Color fundus photograph: 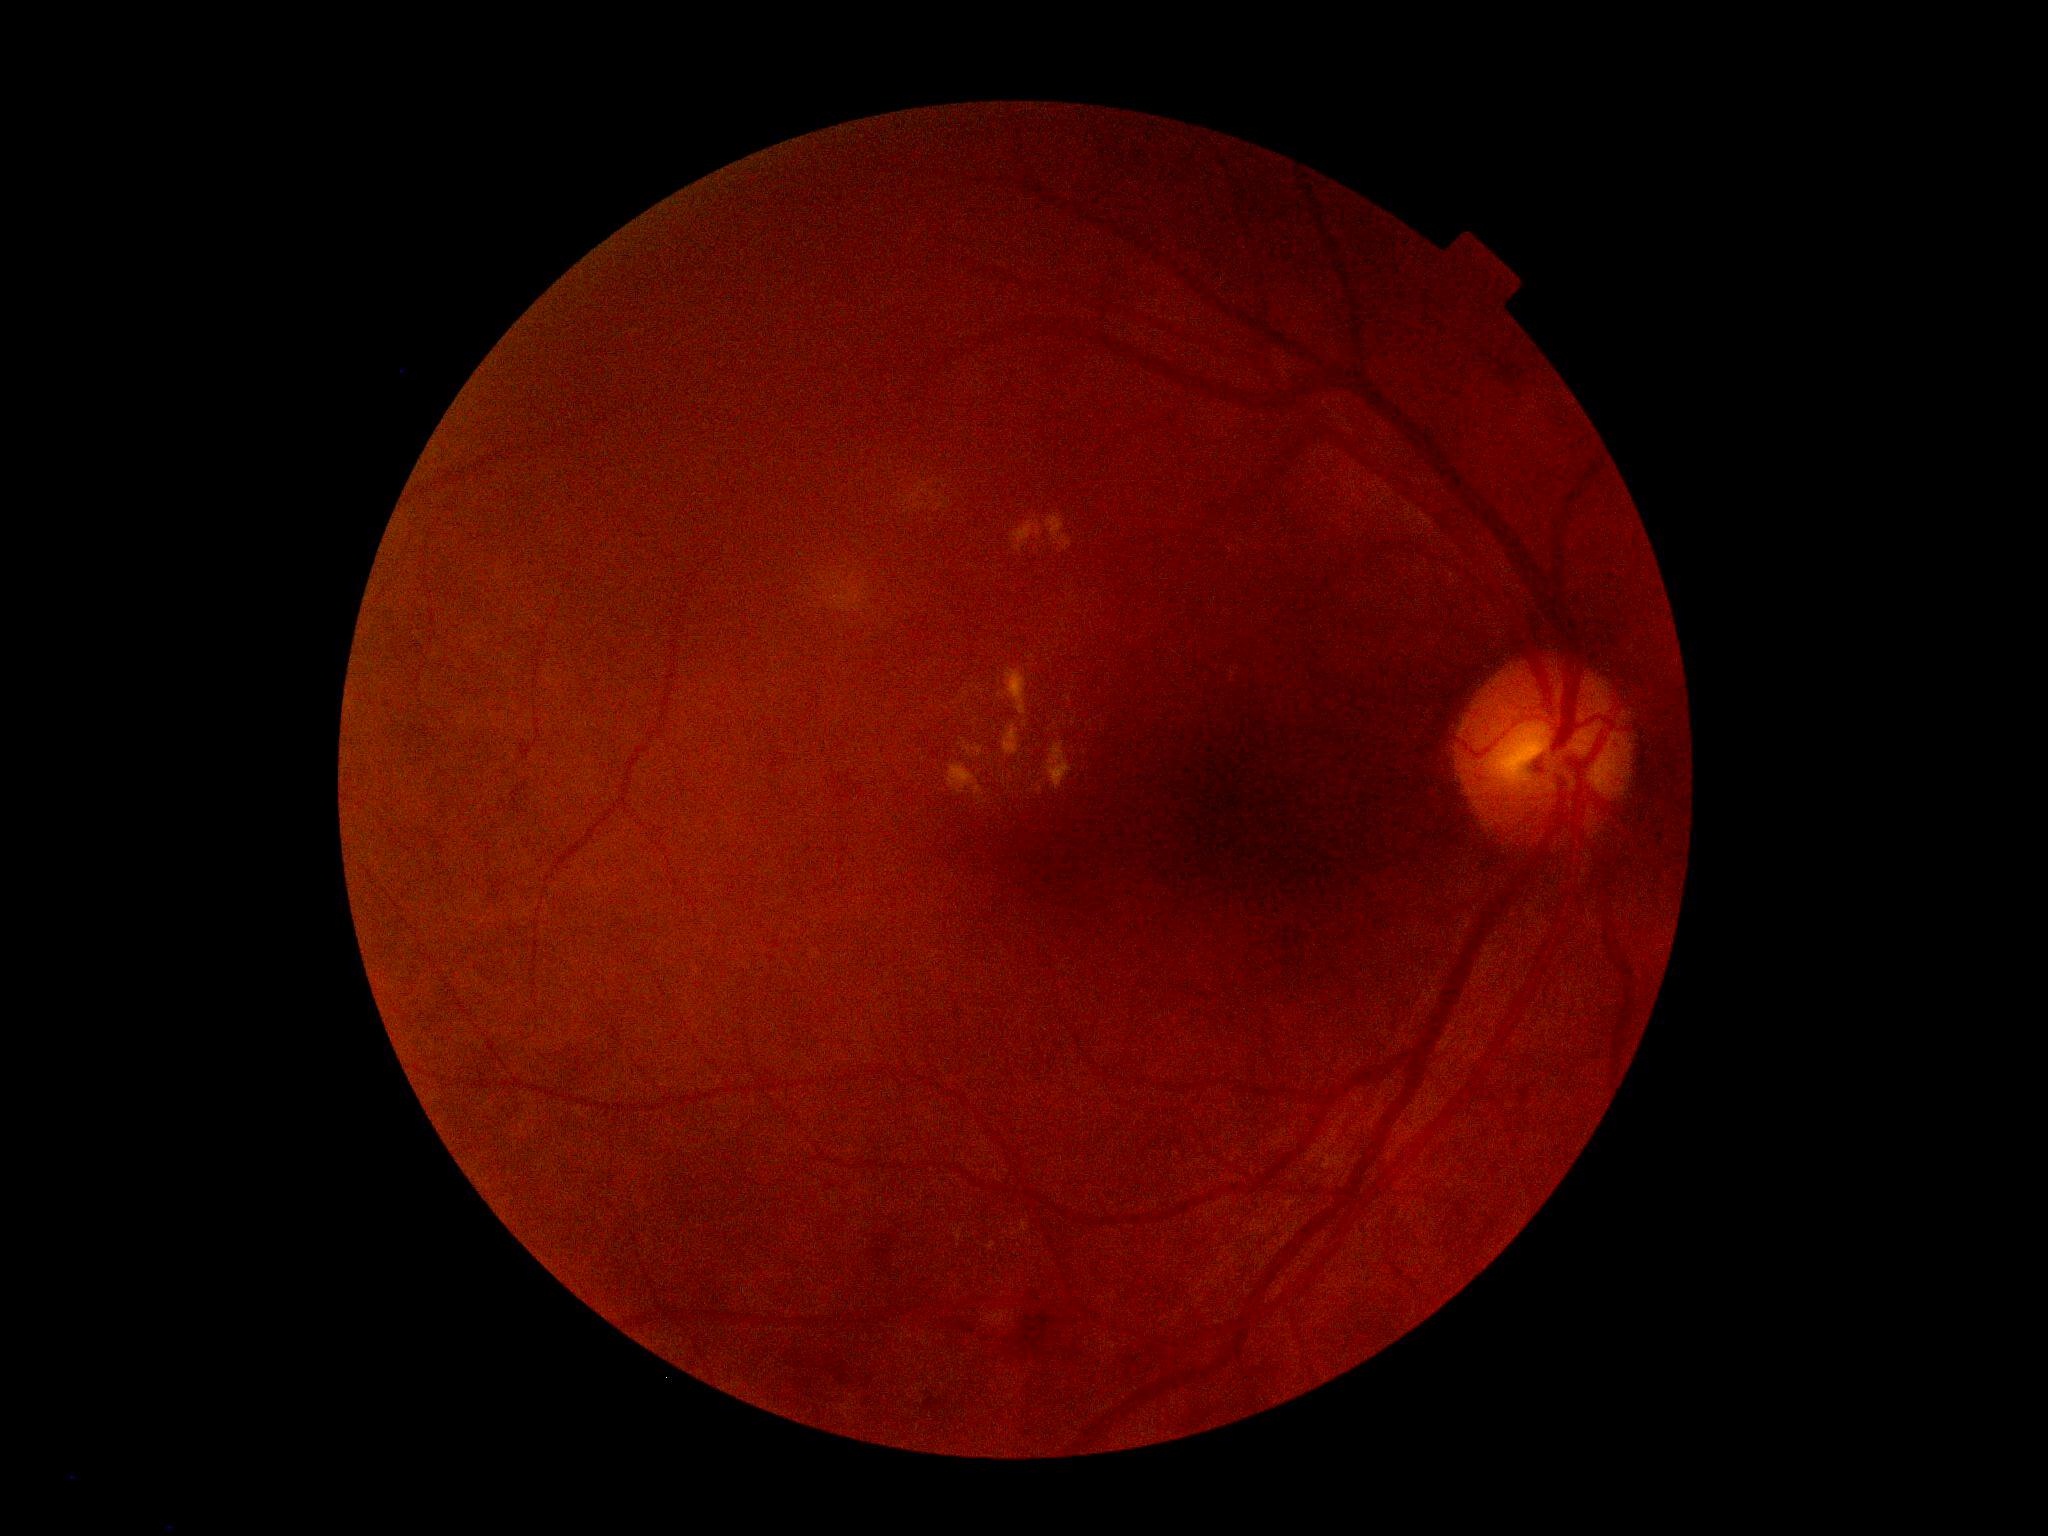

DR class: non-proliferative diabetic retinopathy.
Diabetic retinopathy (DR): moderate NPDR (grade 2).